45° FOV · 2352 x 1568 pixels
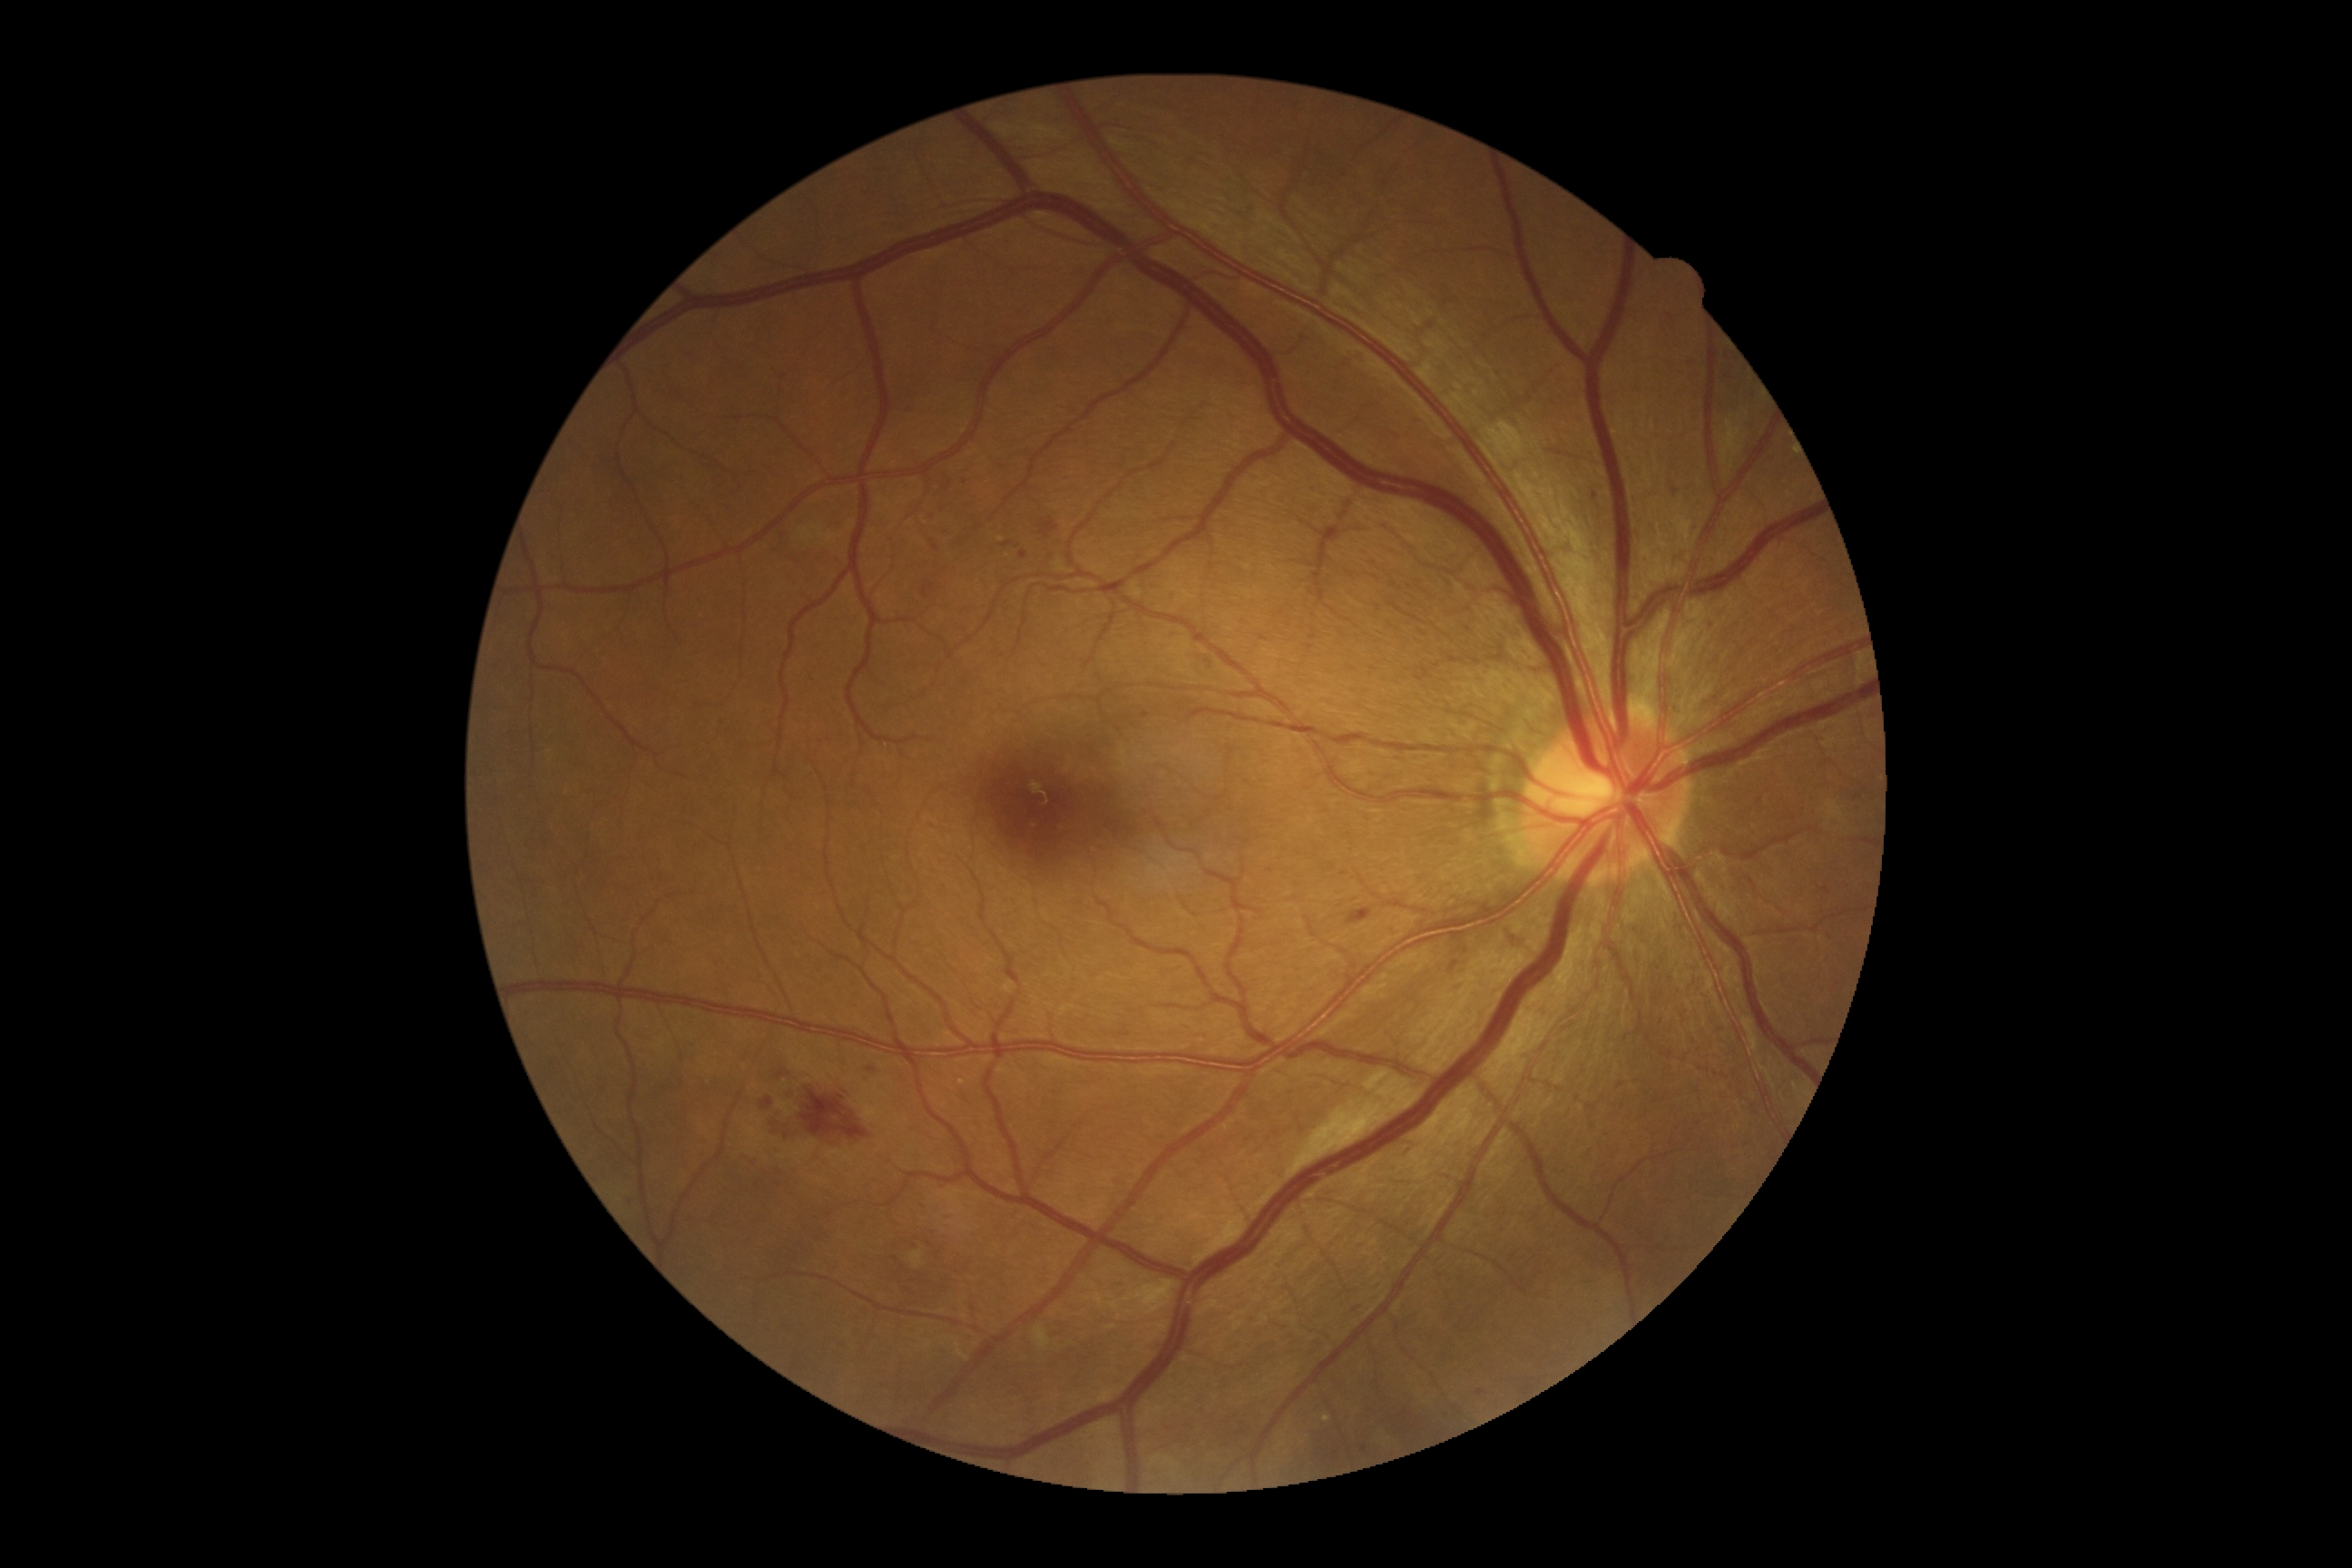 DR grade is moderate NPDR (2).
No EXs identified.
SEs found at BBox(910, 1251, 926, 1269); BBox(1034, 1326, 1052, 1349).
MAs (partial list) at BBox(939, 504, 946, 513); BBox(743, 1153, 750, 1161); BBox(1142, 712, 1150, 720); BBox(868, 1068, 876, 1073); BBox(1019, 553, 1028, 560); BBox(926, 511, 934, 518); BBox(1476, 1389, 1485, 1396); BBox(774, 1148, 783, 1153).
Additional small MAs near 895, 1259; 943, 530; 949, 485; 1595, 497; 966, 483; 936, 548; 1364, 1450; 866, 1080; 780, 1170; 631, 1200.
HEs (partial list) at BBox(769, 1088, 868, 1141); BBox(943, 471, 952, 495); BBox(1001, 542, 1012, 547); BBox(783, 1090, 798, 1102); BBox(945, 1213, 954, 1219); BBox(1348, 908, 1373, 925); BBox(761, 1097, 772, 1110); BBox(923, 583, 934, 598); BBox(1041, 518, 1059, 536); BBox(778, 1072, 787, 1079); BBox(910, 1240, 919, 1246); BBox(919, 1228, 937, 1235).
Additional small HEs near 922, 1207.